1659 x 2212 pixels: 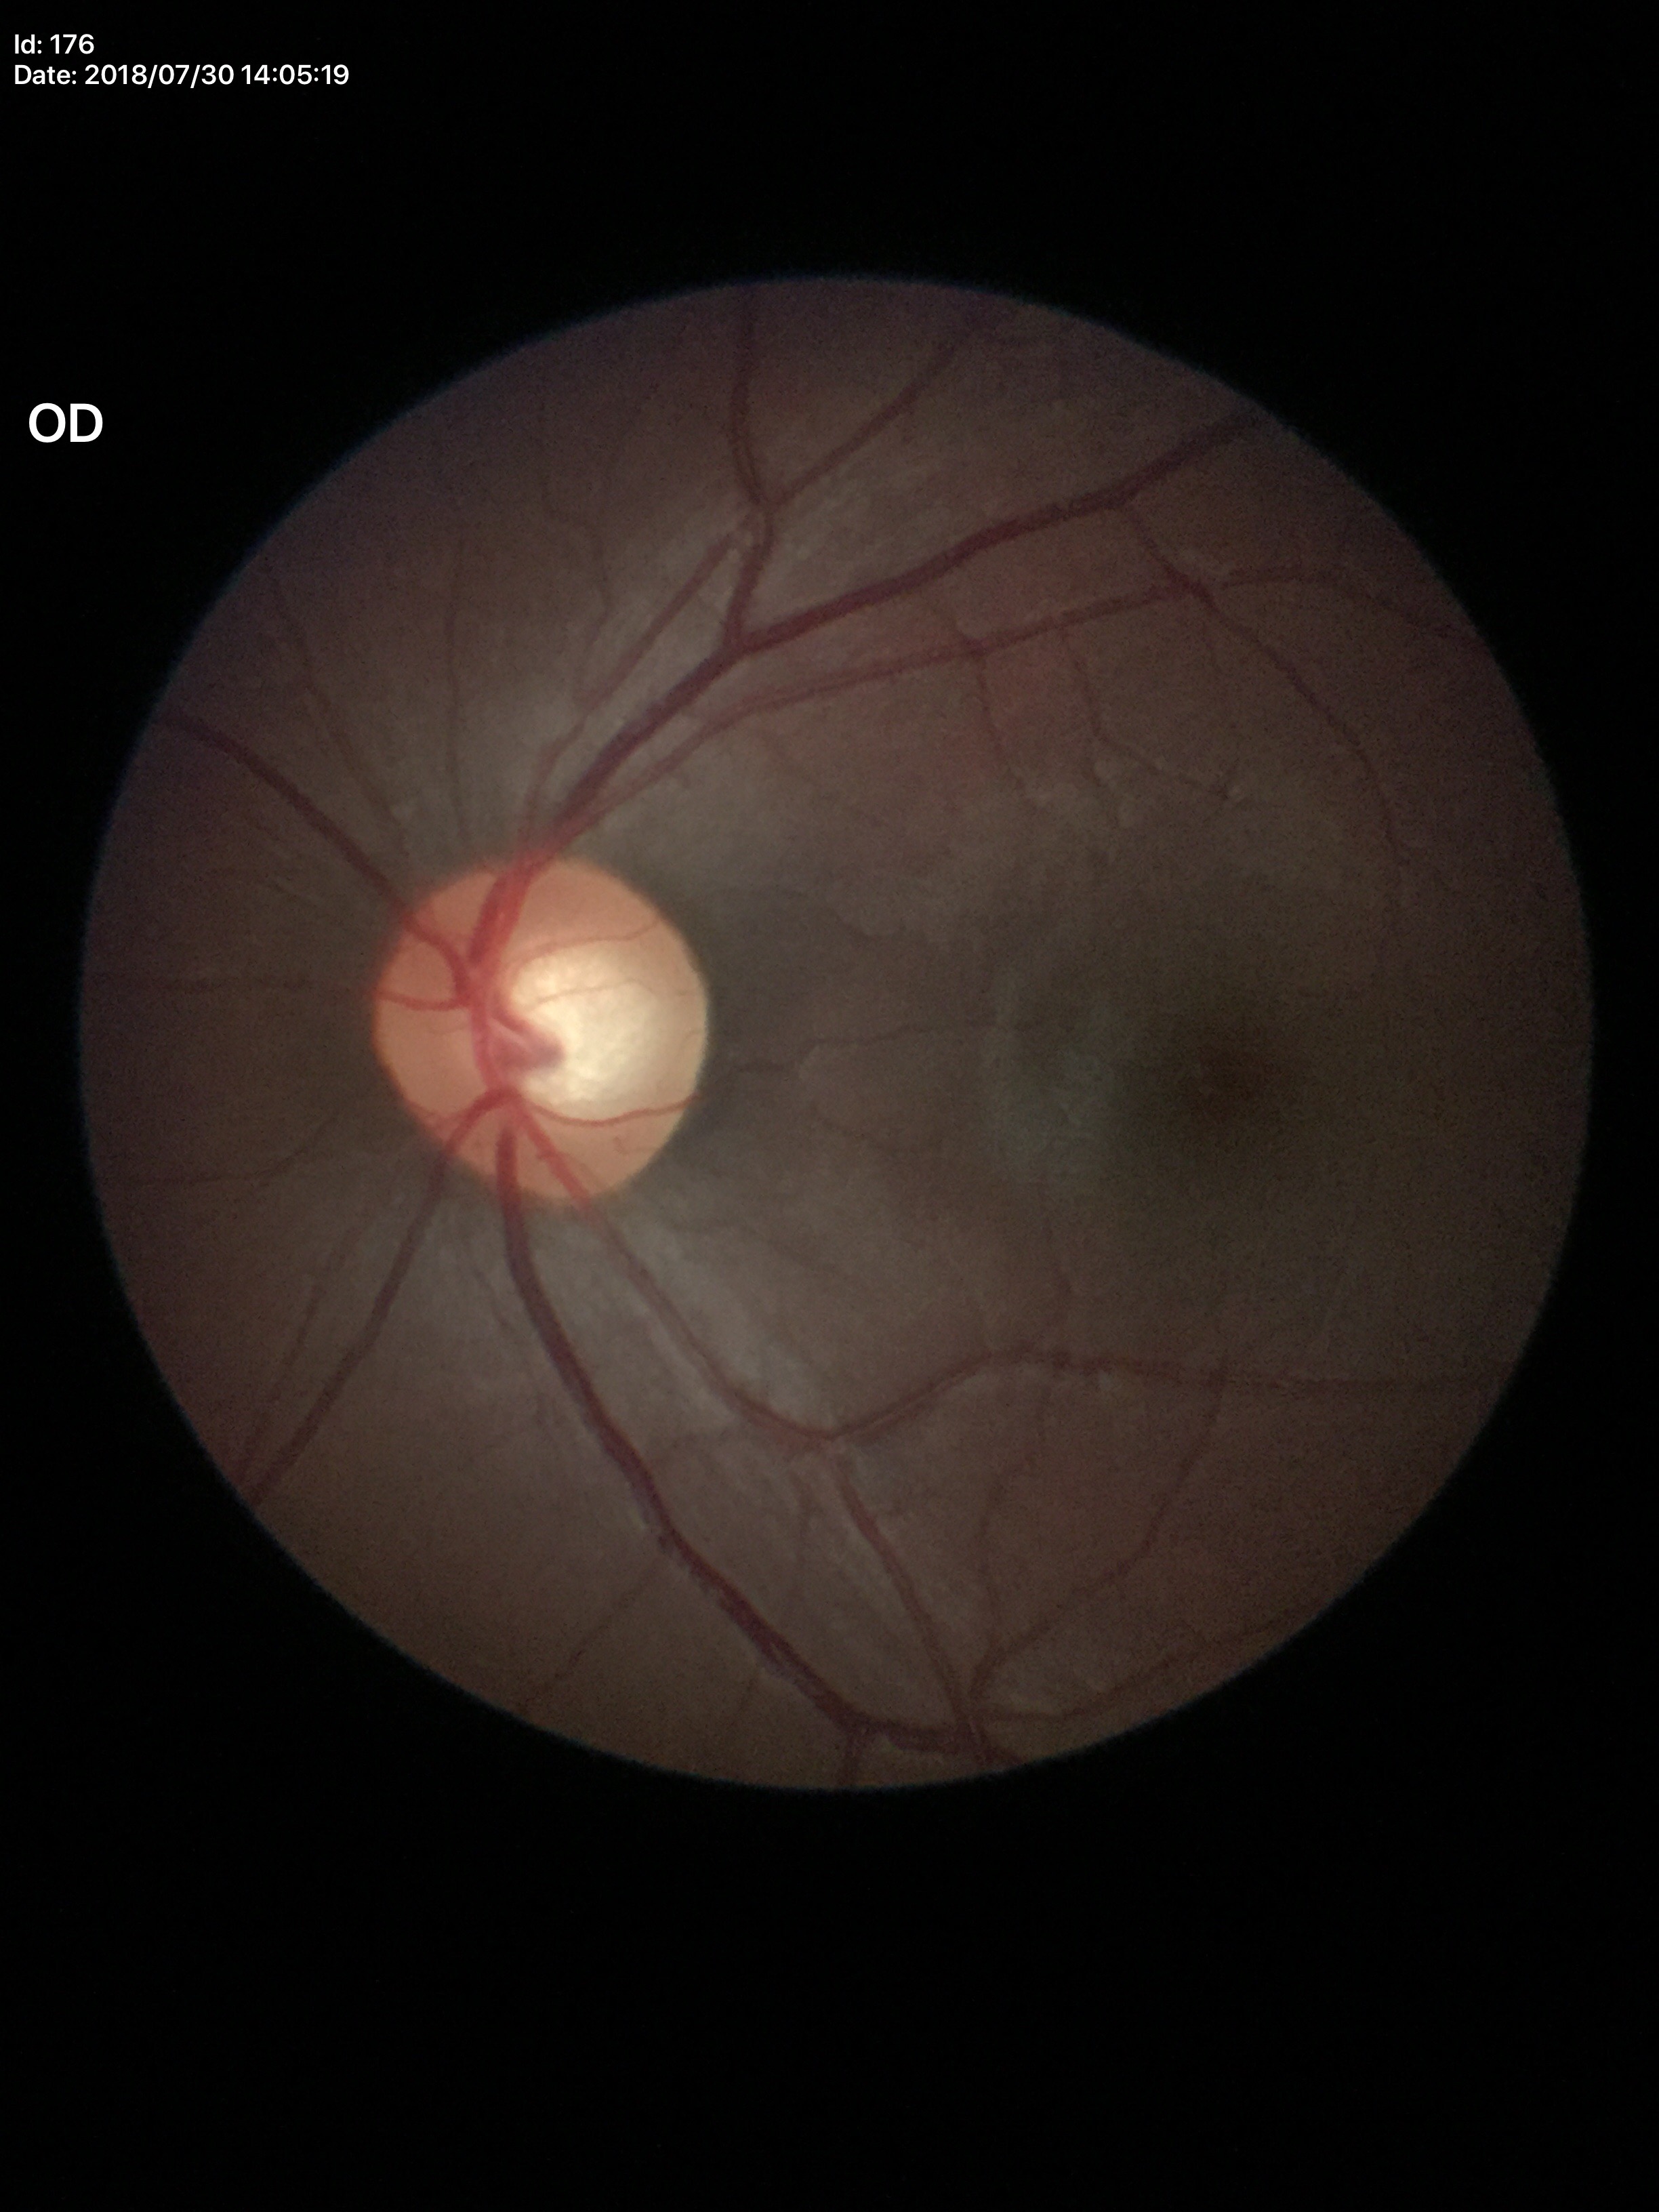

• vertical cup-disc ratio (VCDR): 0.61
• horizontal cup-disc ratio (HCDR): 0.60
• Glaucoma decision: suspect